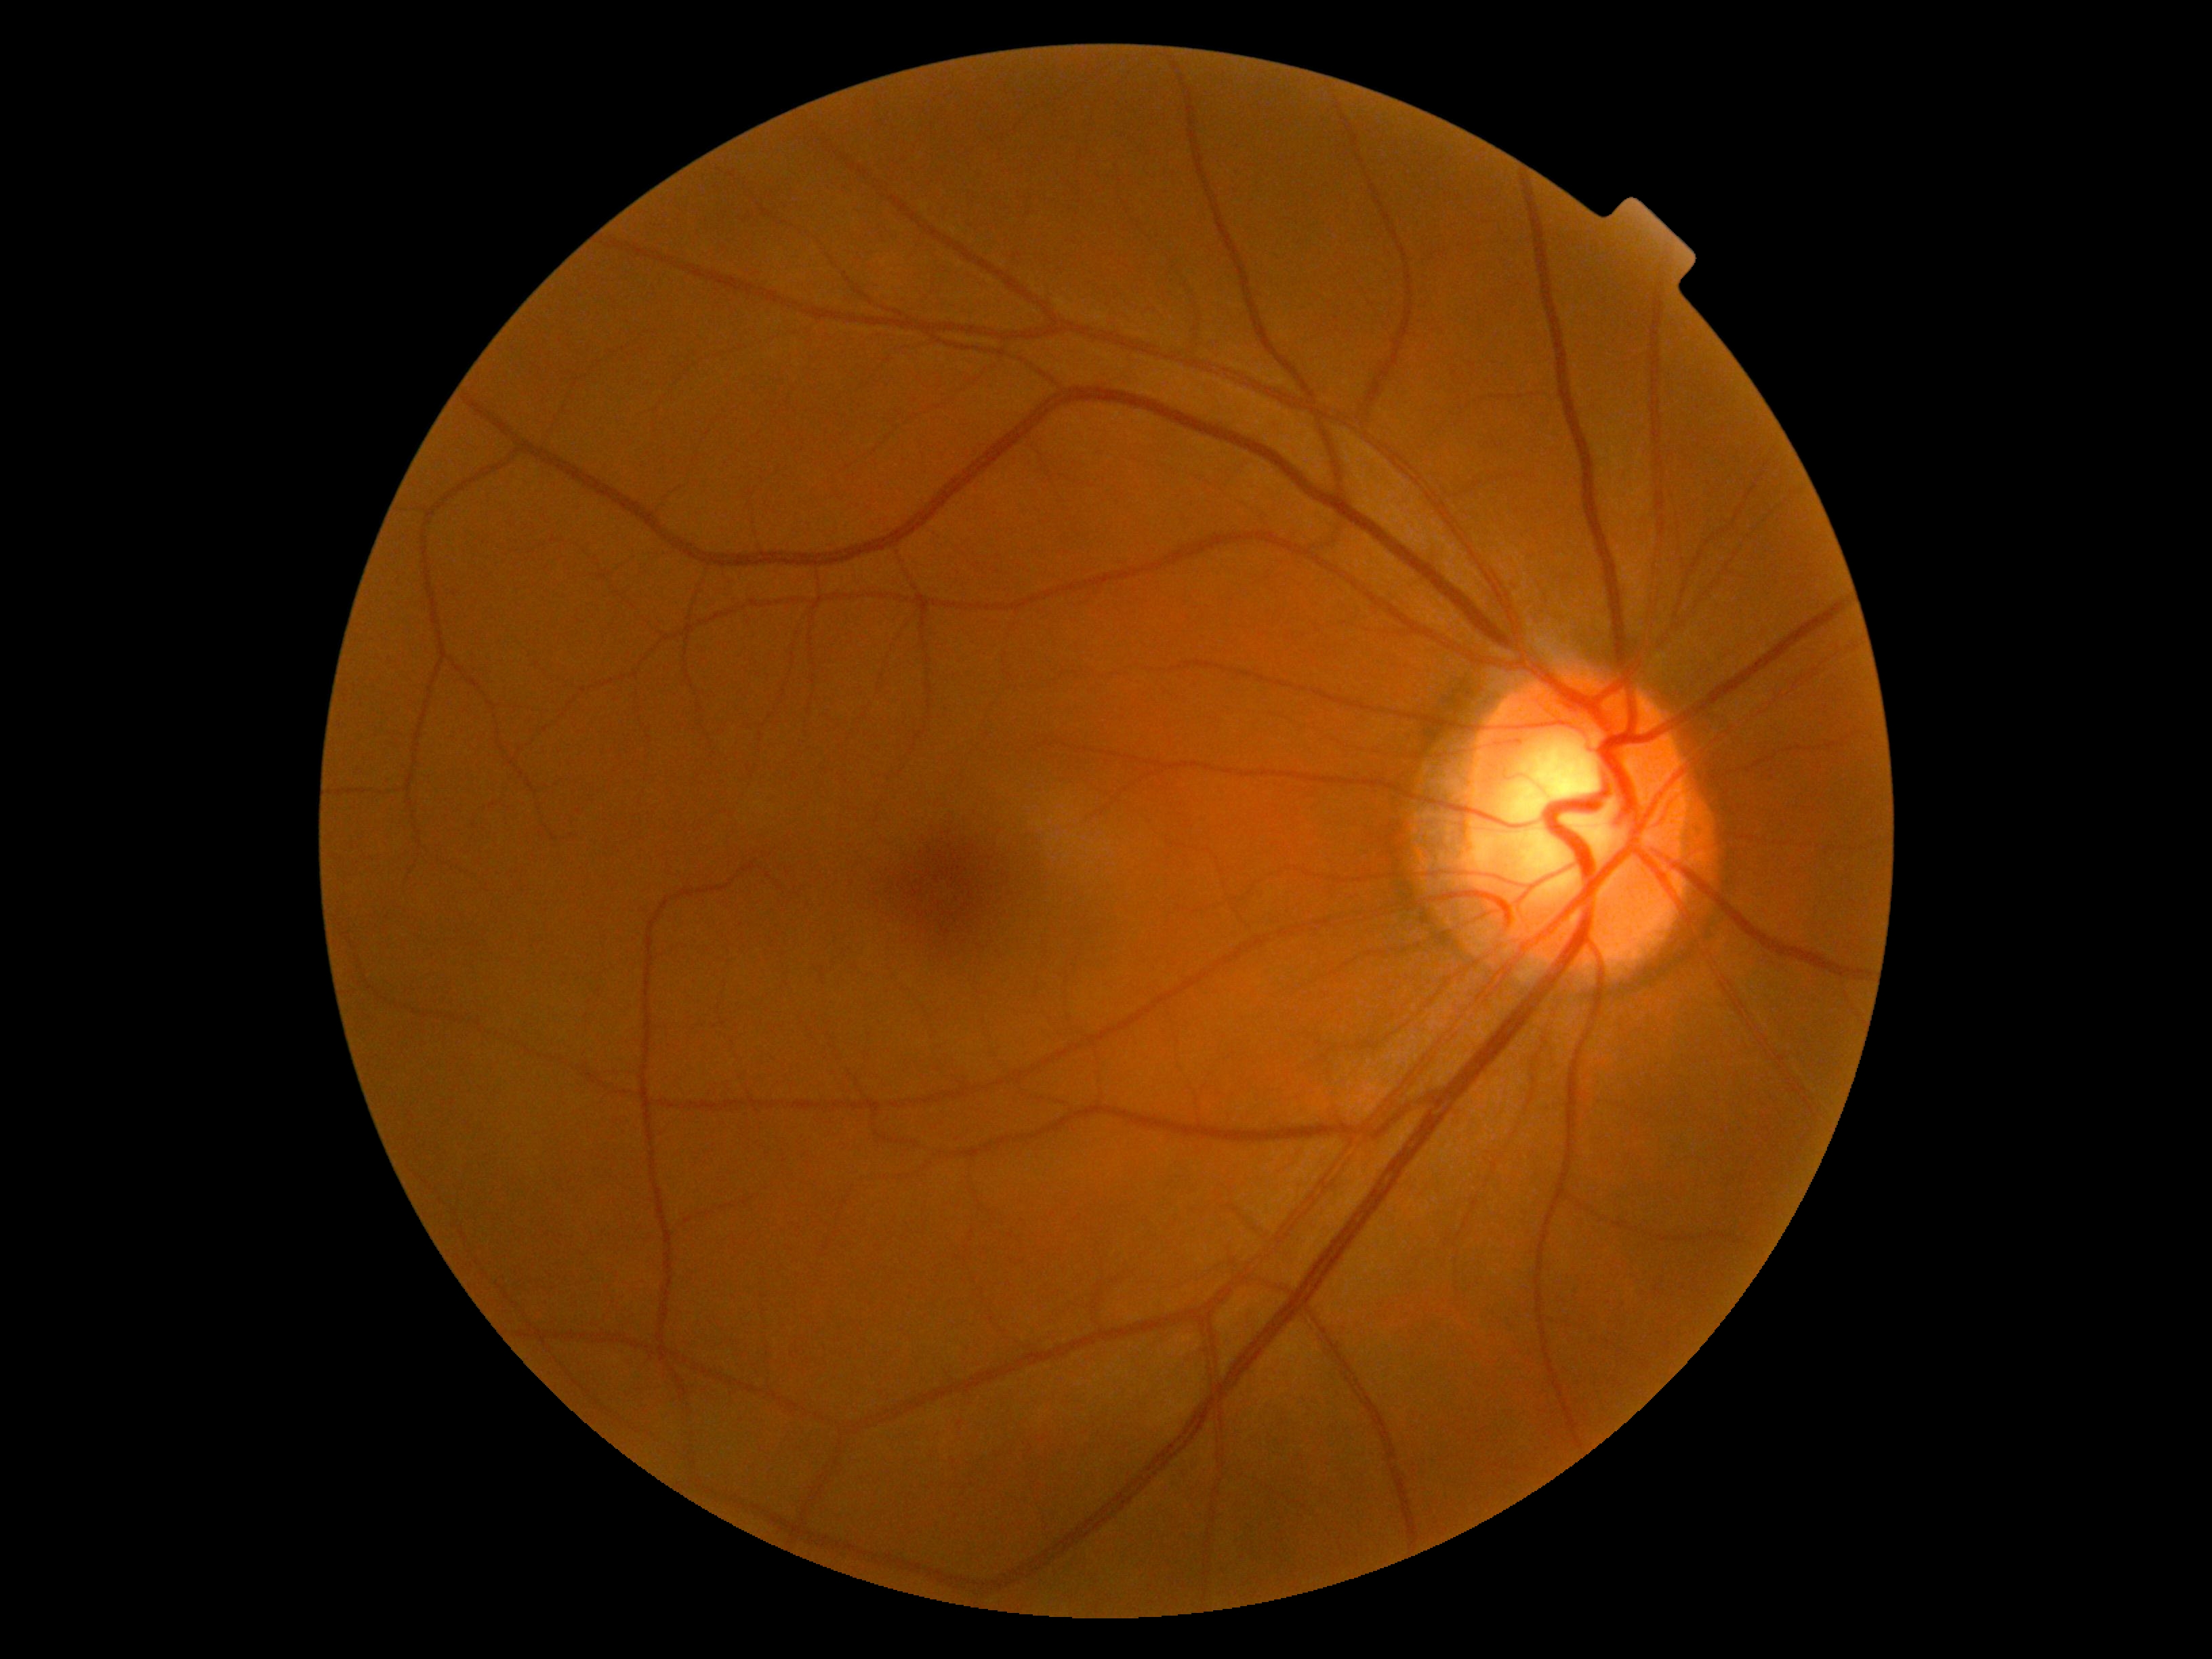 No apparent diabetic retinopathy. Diabetic retinopathy (DR) is grade 0 (no apparent retinopathy).